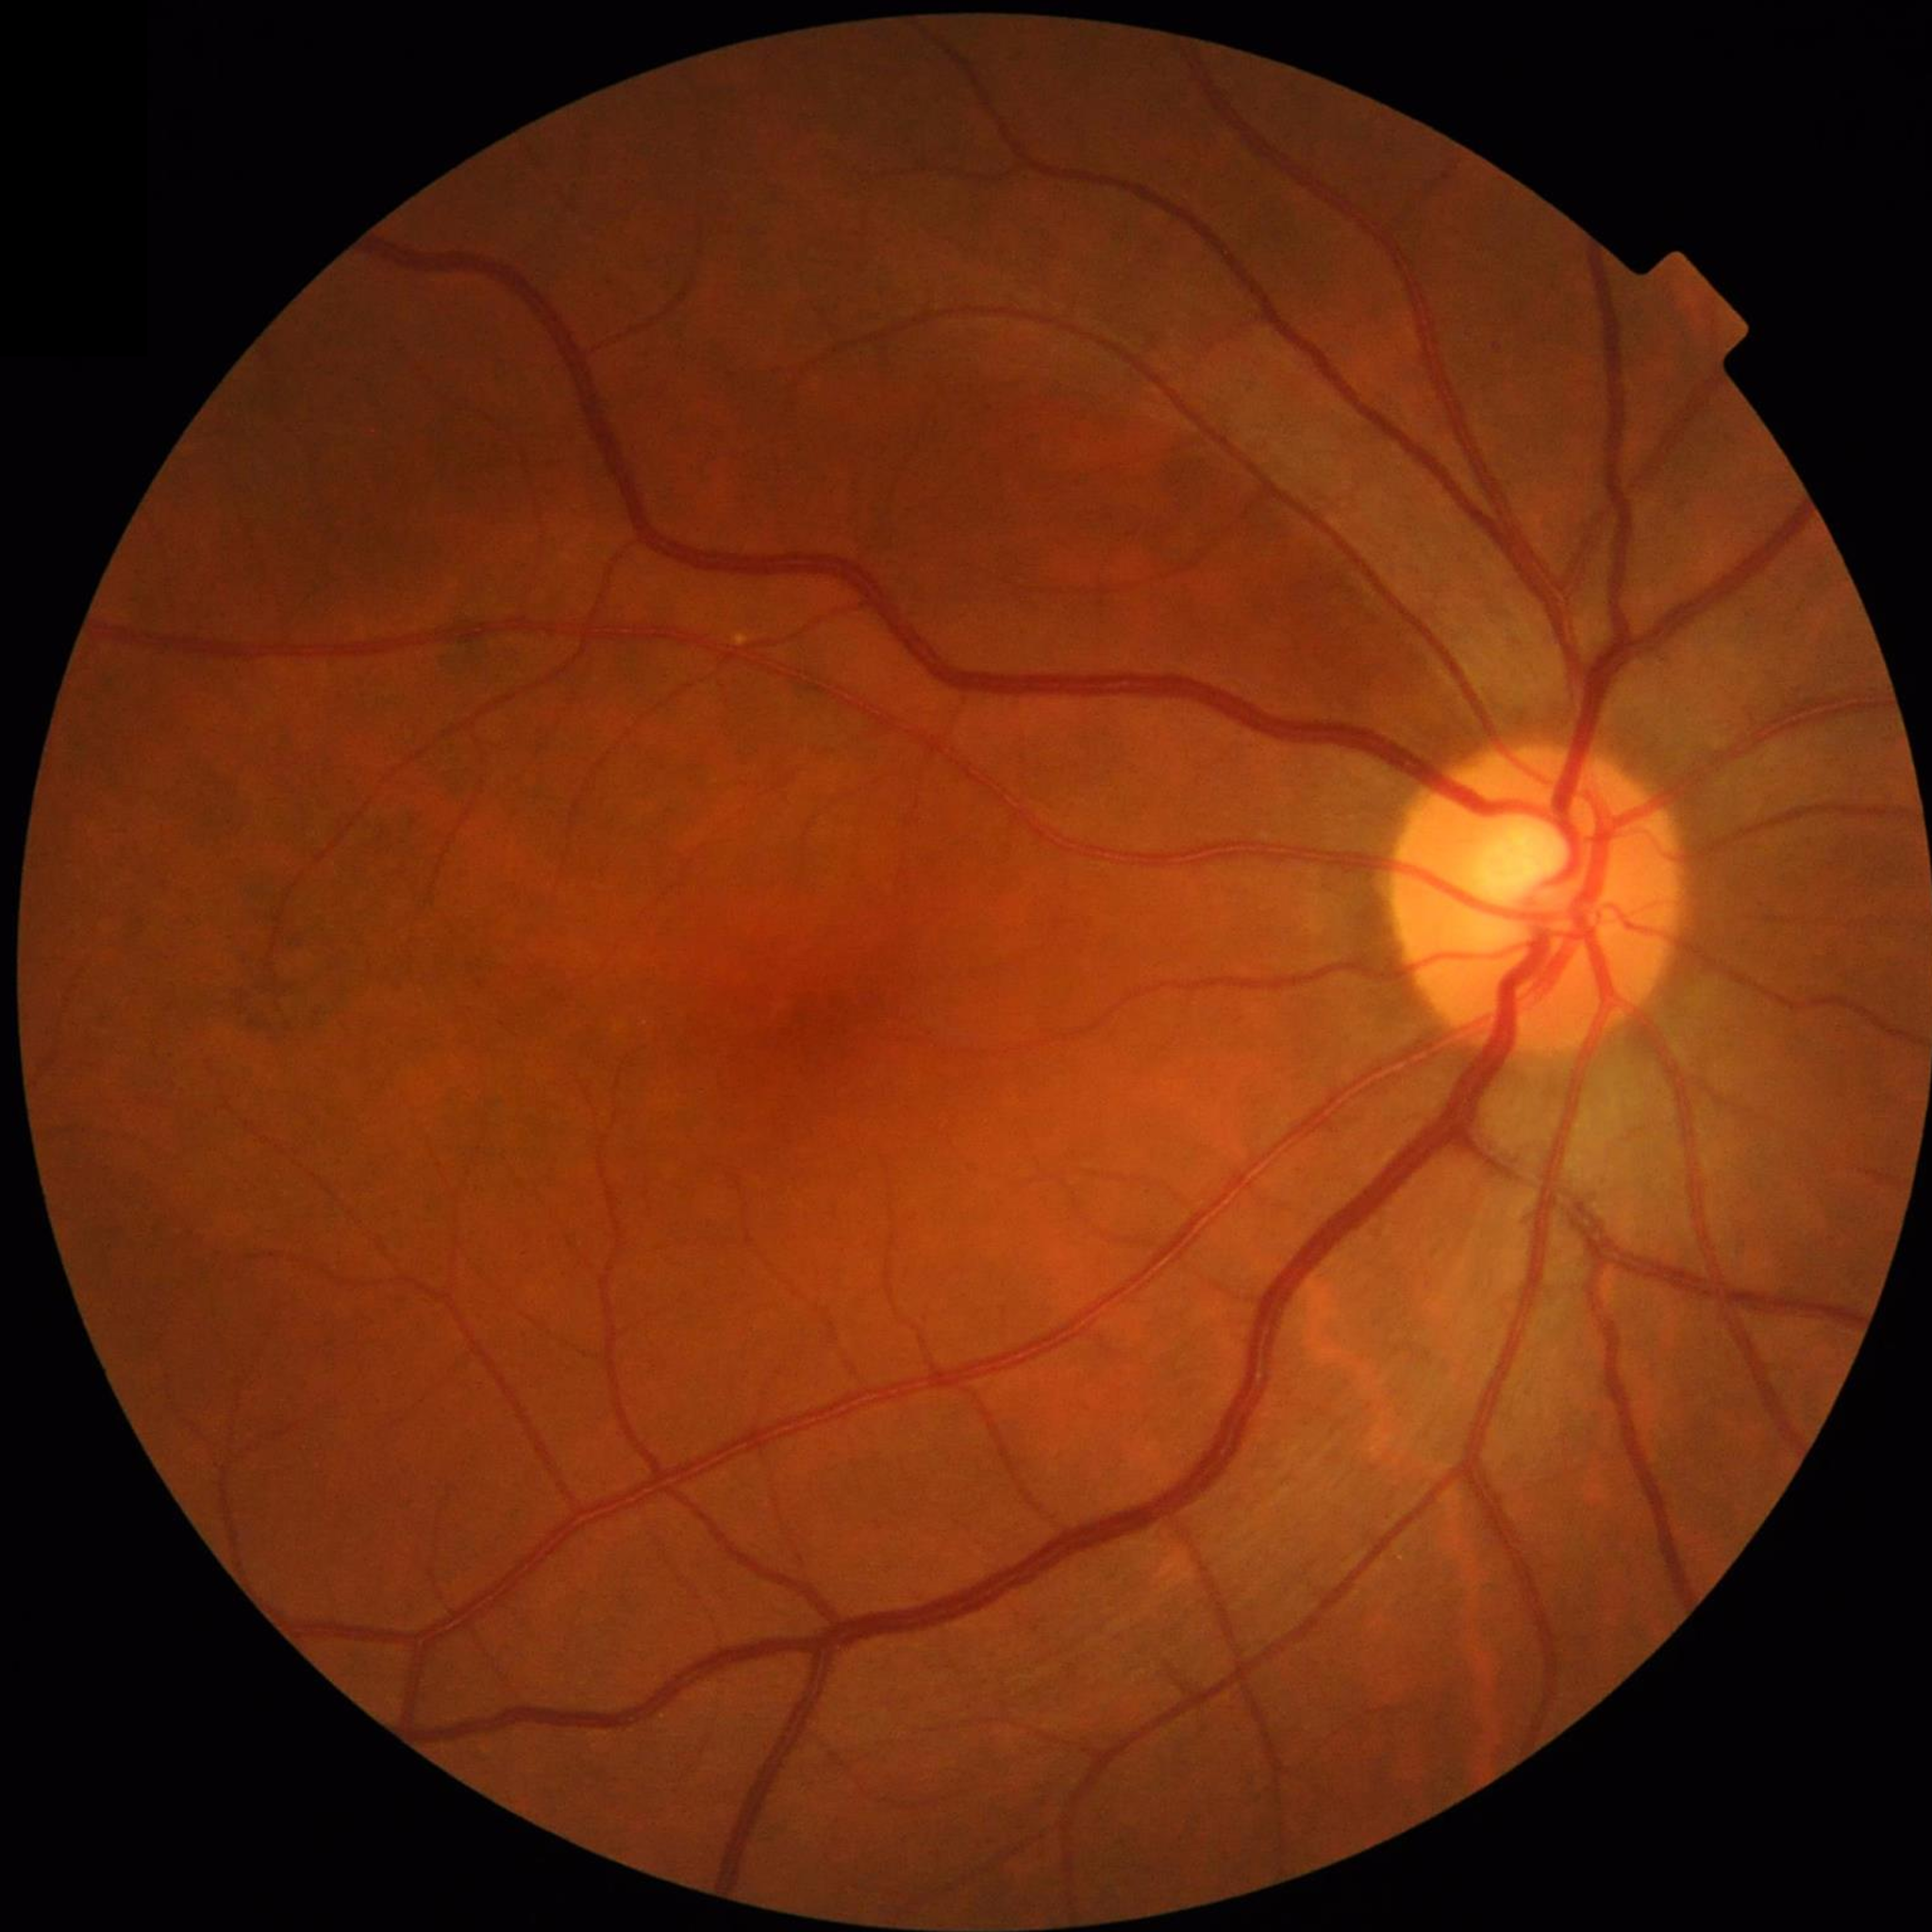

Disease class: no AMD, DR, or glaucoma.